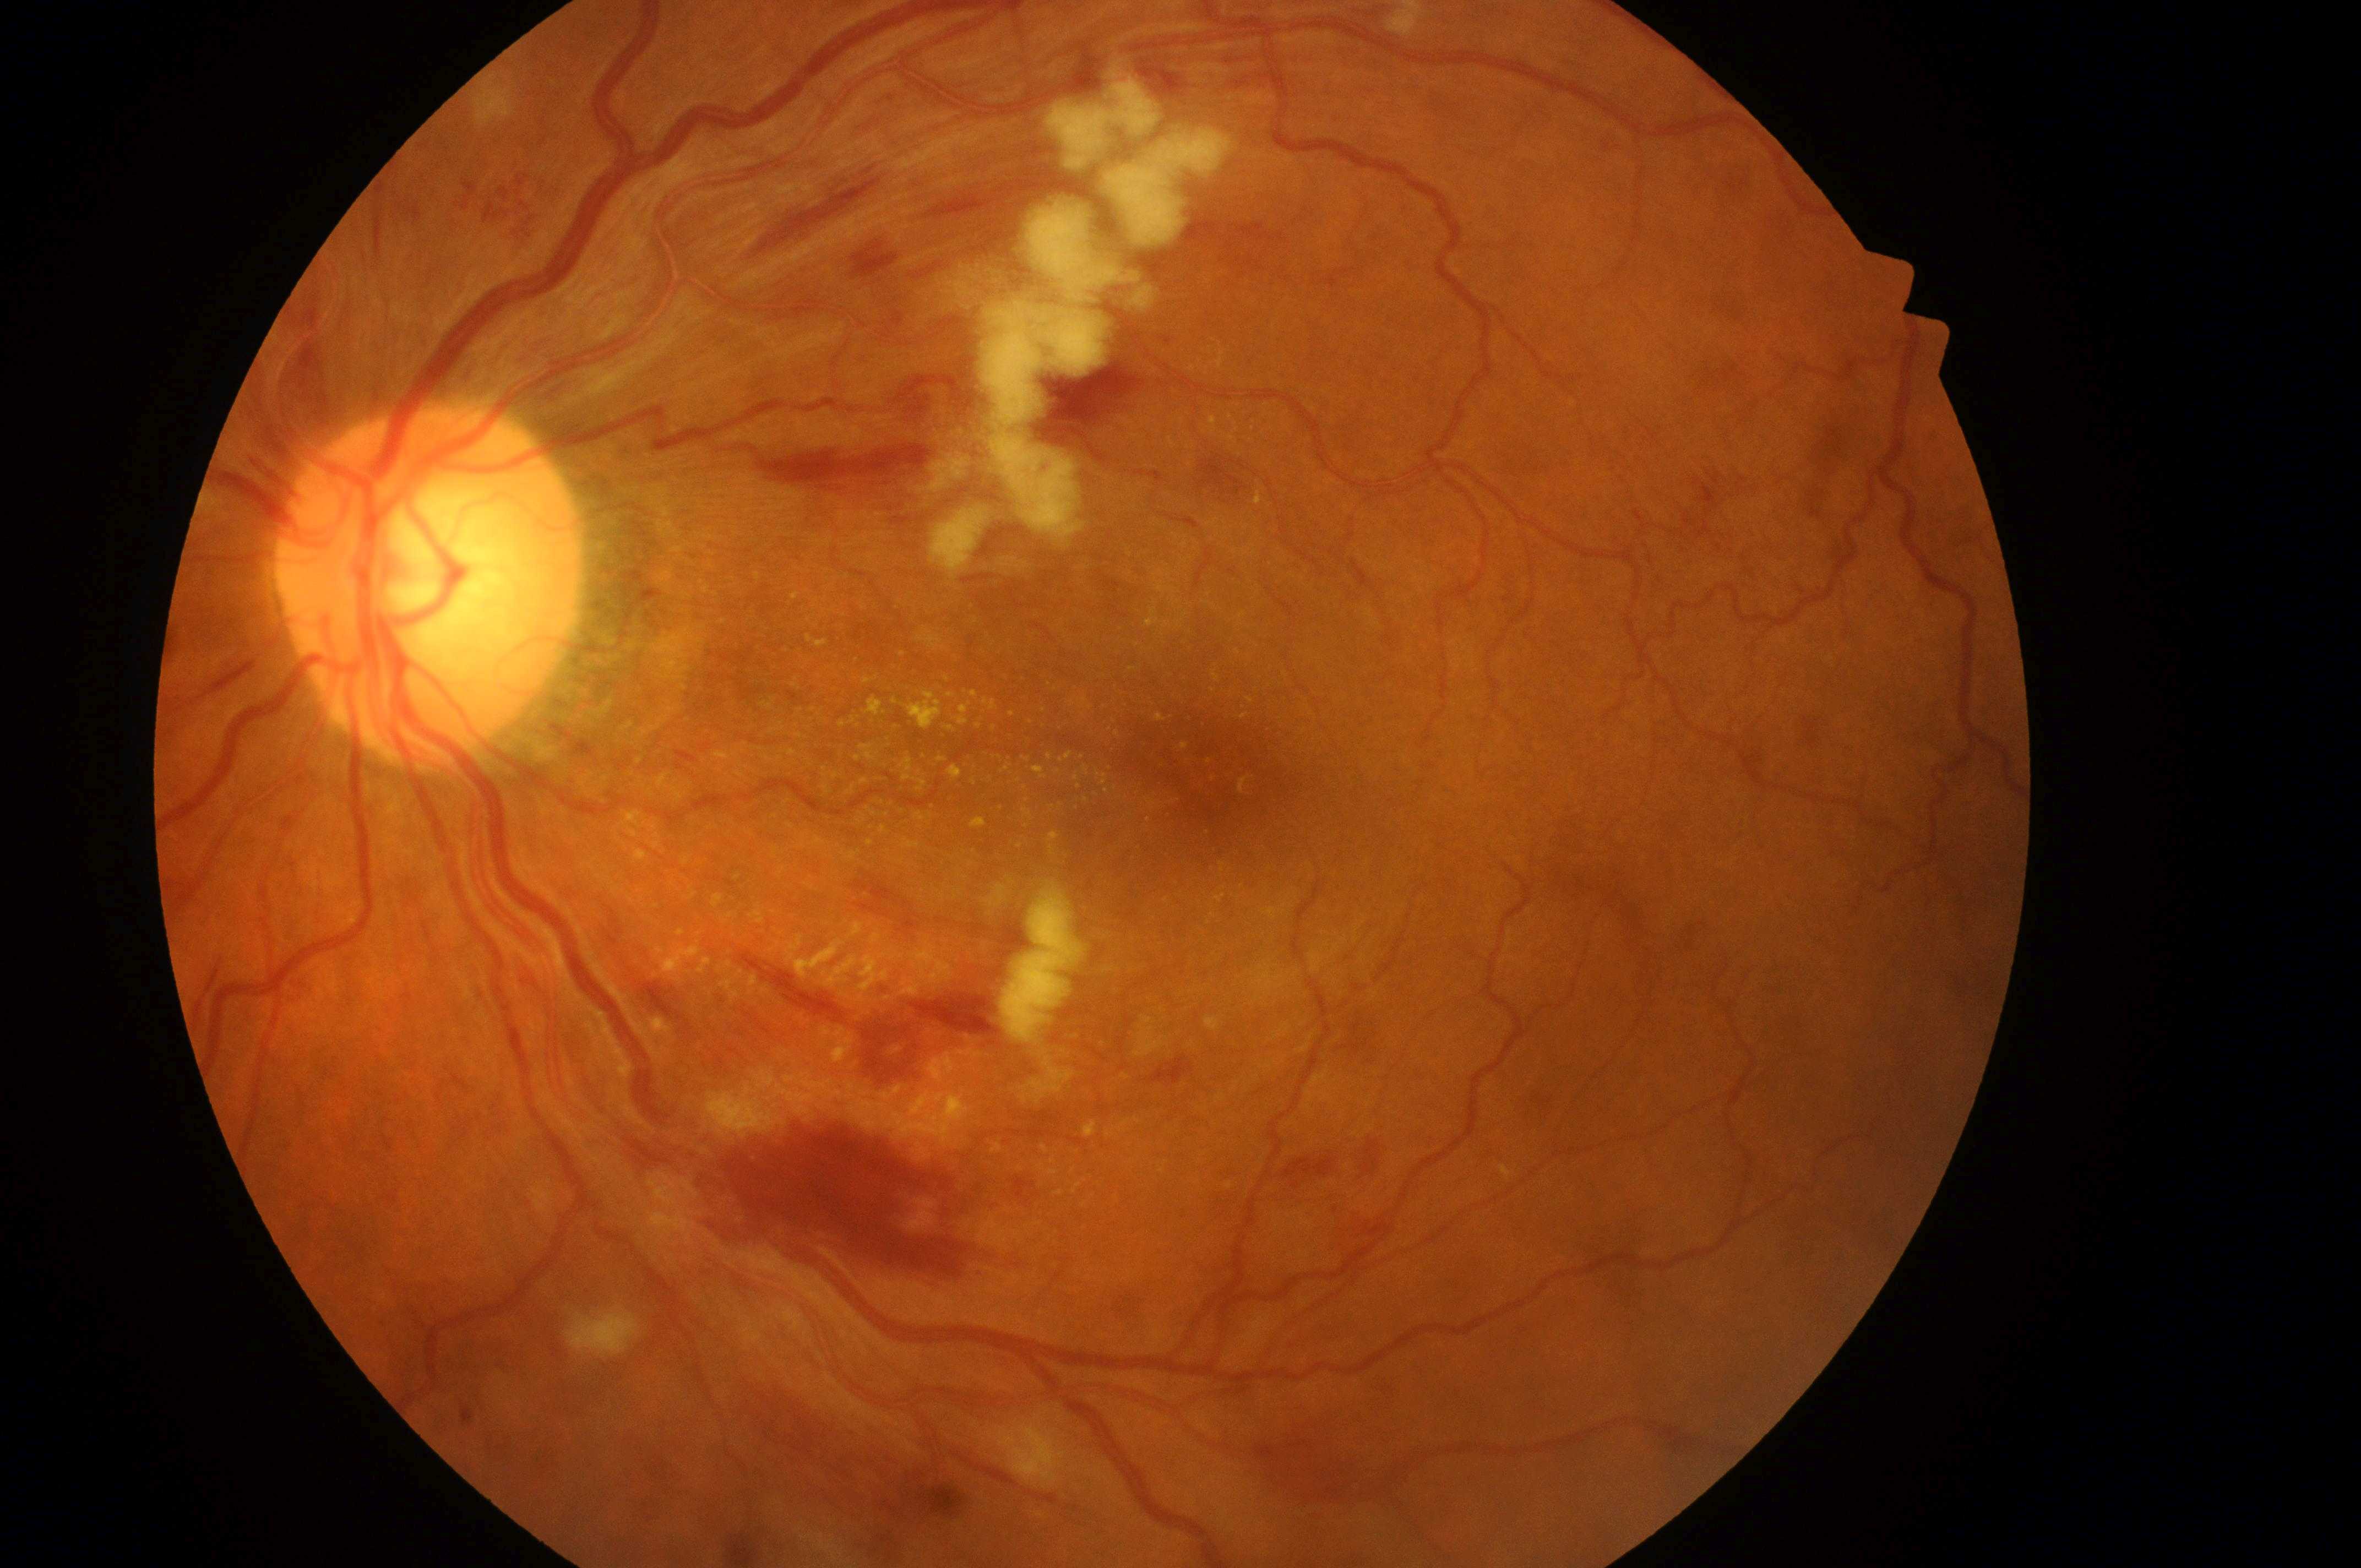 fovea center@(x=1200, y=775); OS; optic disk@(x=421, y=596); DME risk@grade 2 (high risk); DR severity@severe NPDR (grade 3).